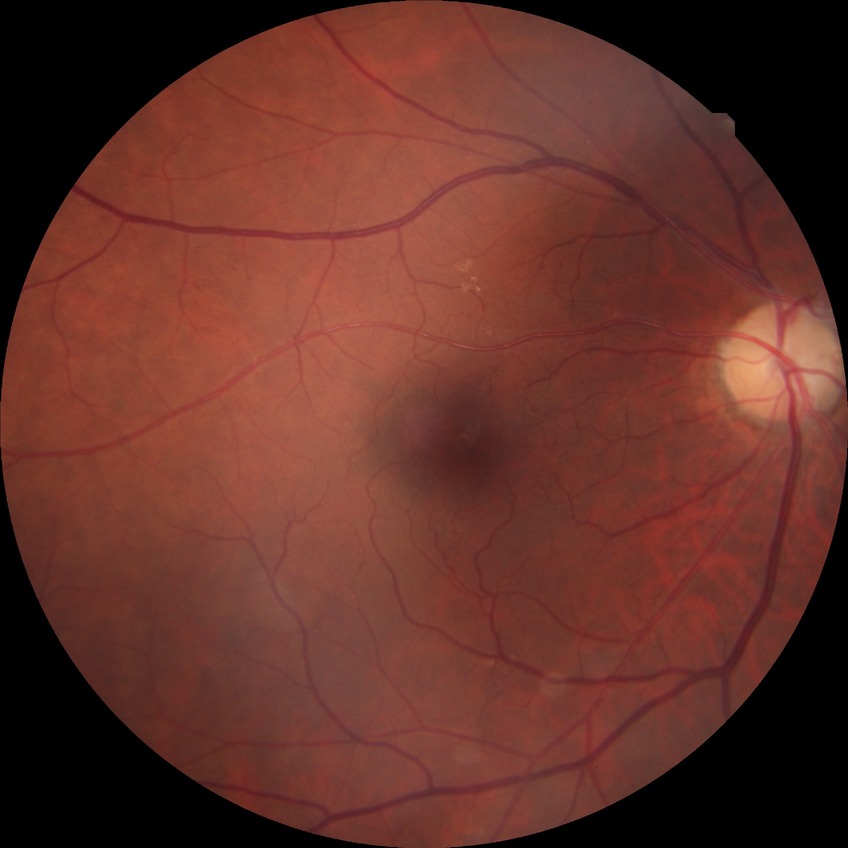

{"davis_grade": "pre-proliferative diabetic retinopathy"}